Infant wide-field retinal image:
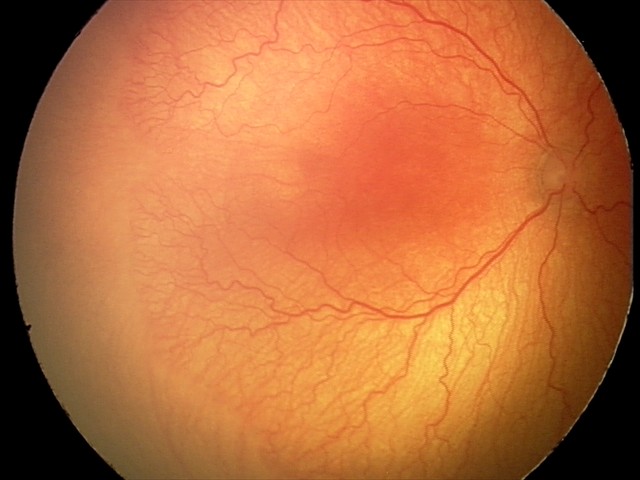
Plus disease present. Series diagnosed as aggressive ROP (A-ROP).